Color fundus photograph.
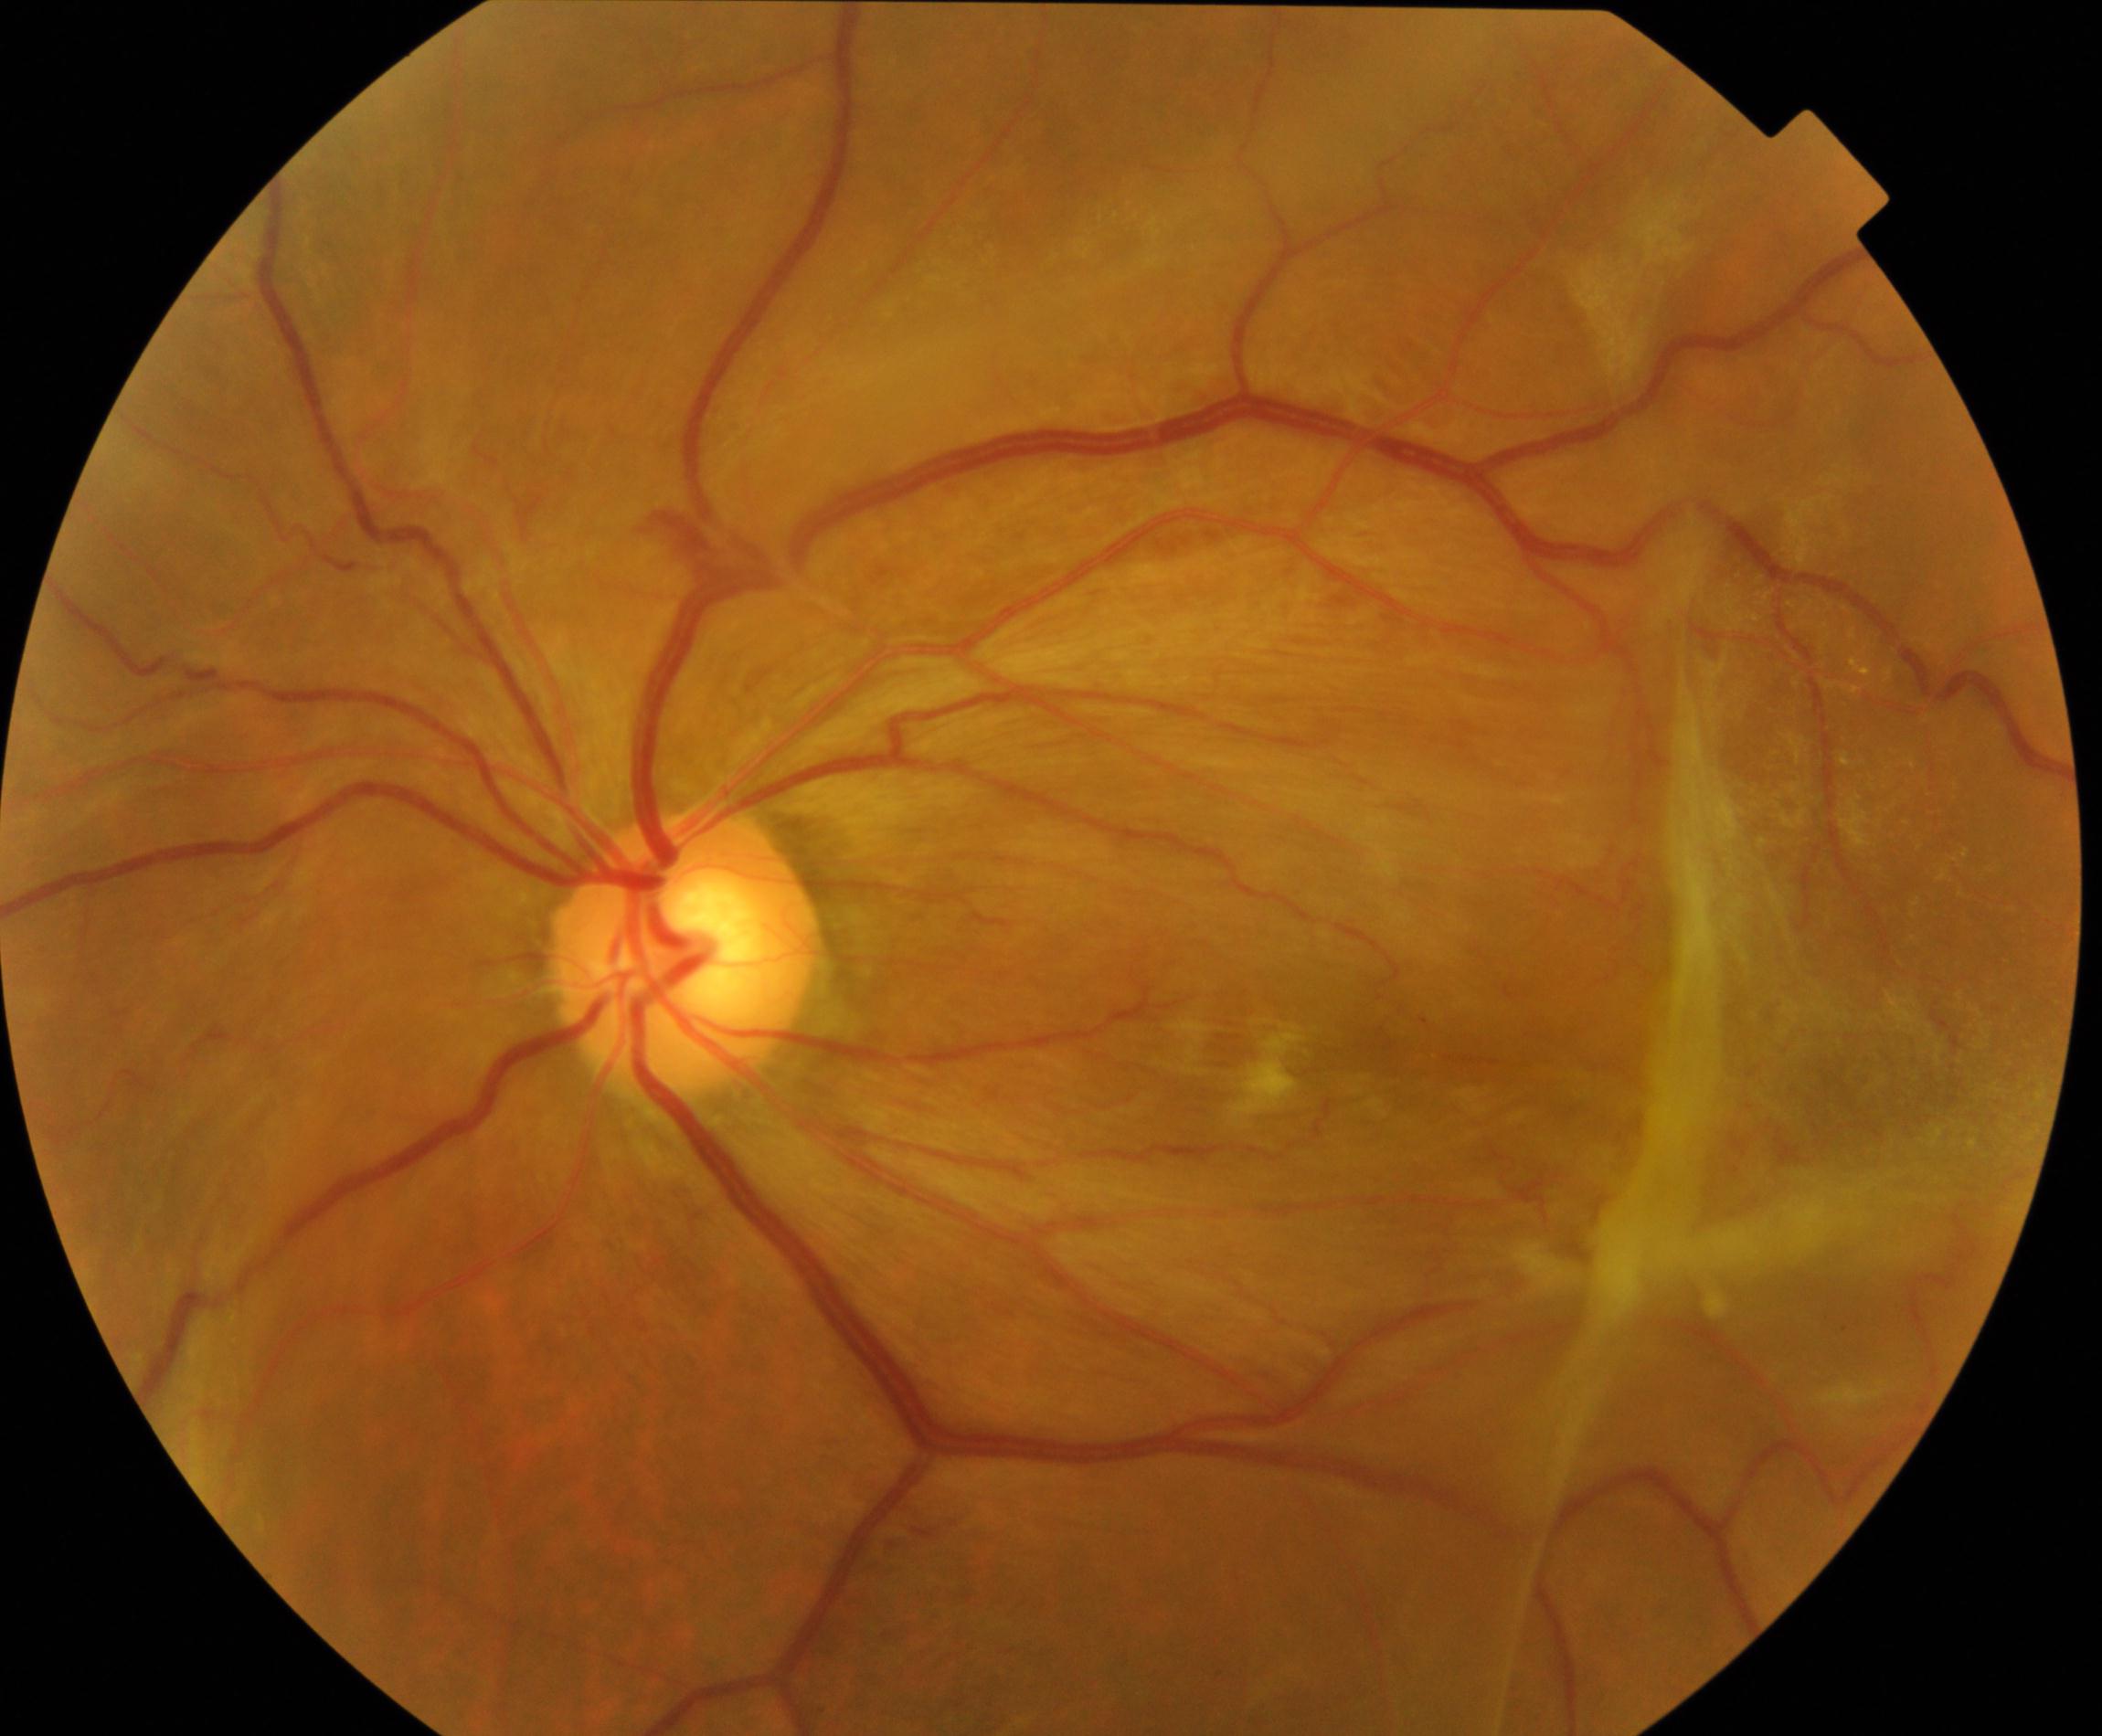 Diagnosis: fibrosis.